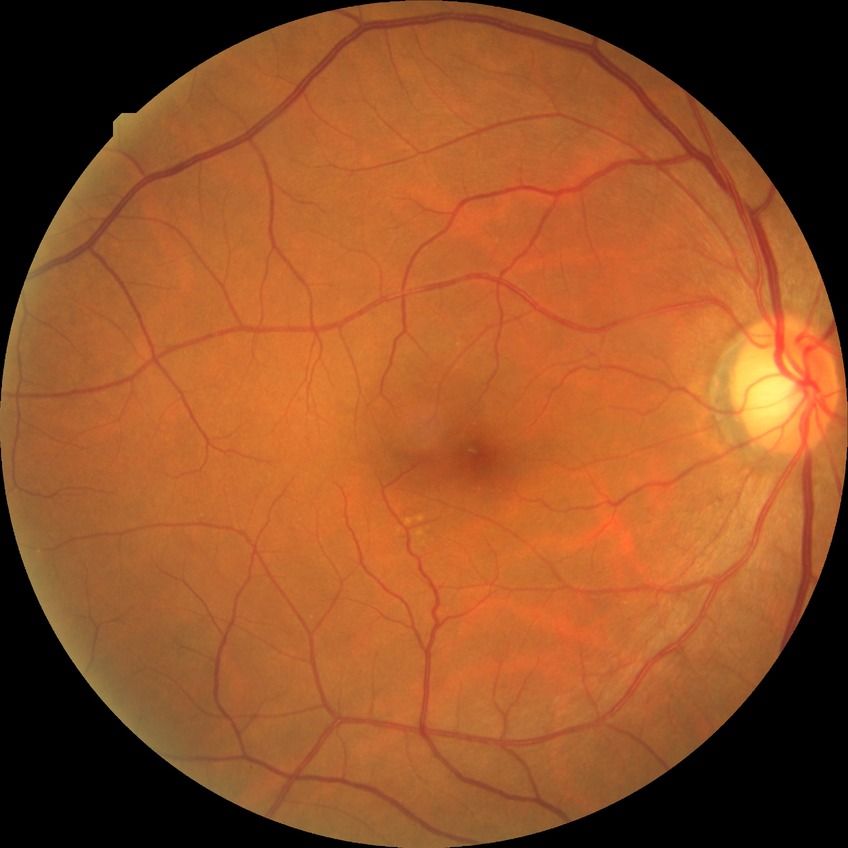

diabetic retinopathy (DR)@no diabetic retinopathy (NDR).